1240 by 1240 pixels. Phoenix ICON wide-field infant fundus image:
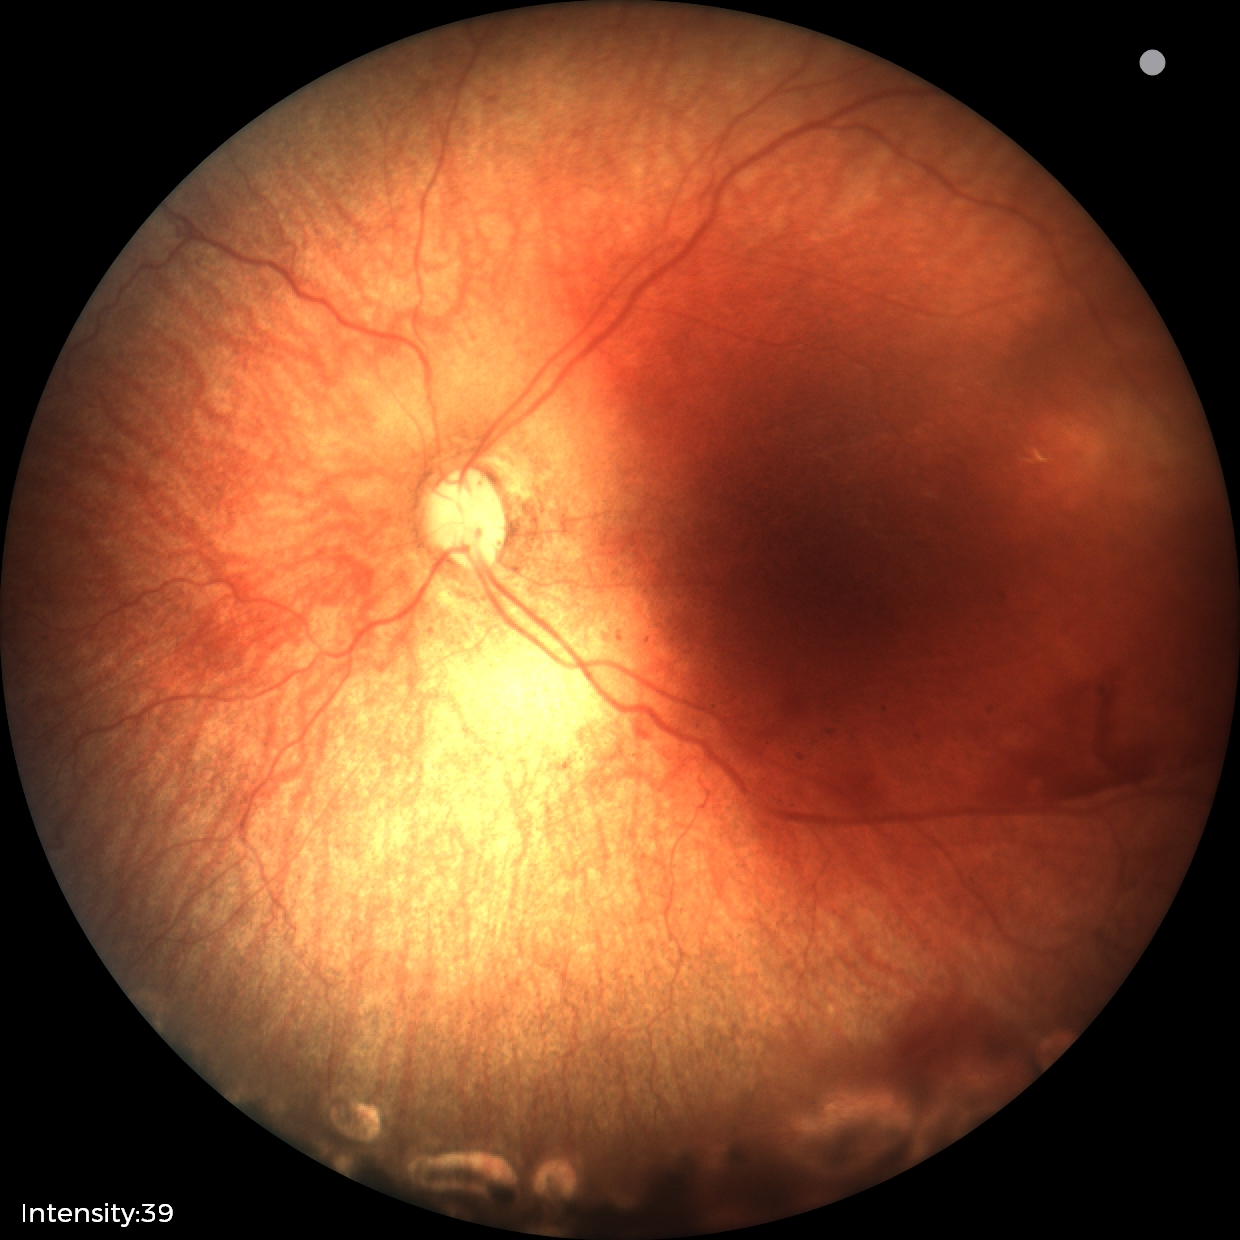 From an examination with diagnosis of status post retinopathy of prematurity — retinal appearance after treated retinopathy of prematurity.